848x848; 45° field of view; without pupil dilation
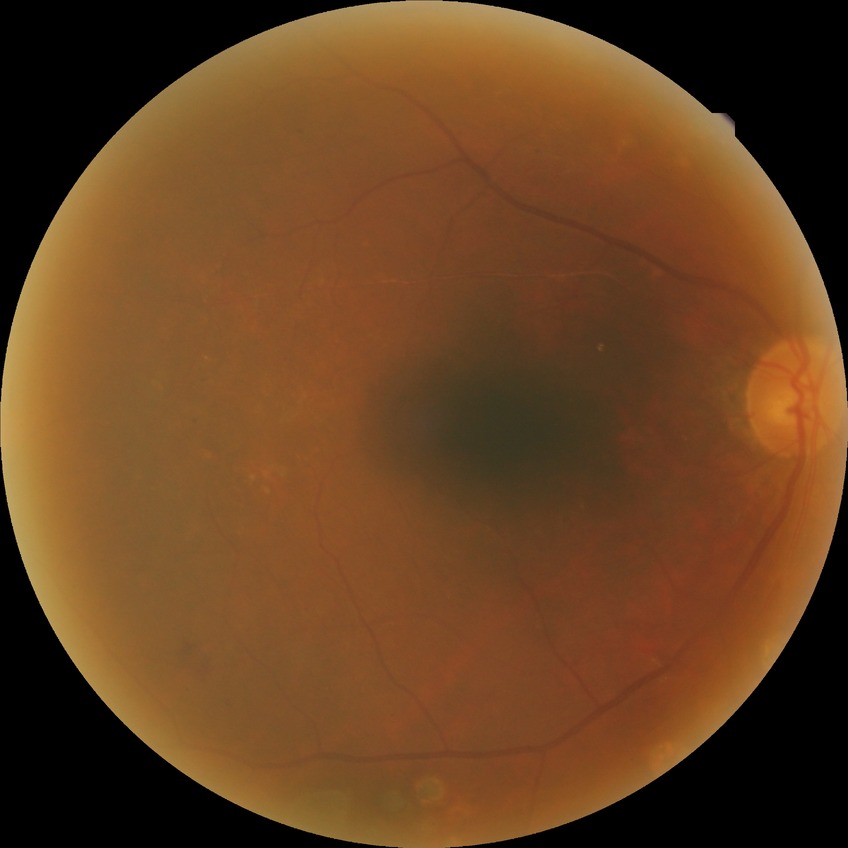
Diabetic retinopathy (DR) is proliferative diabetic retinopathy (PDR).